45° field of view
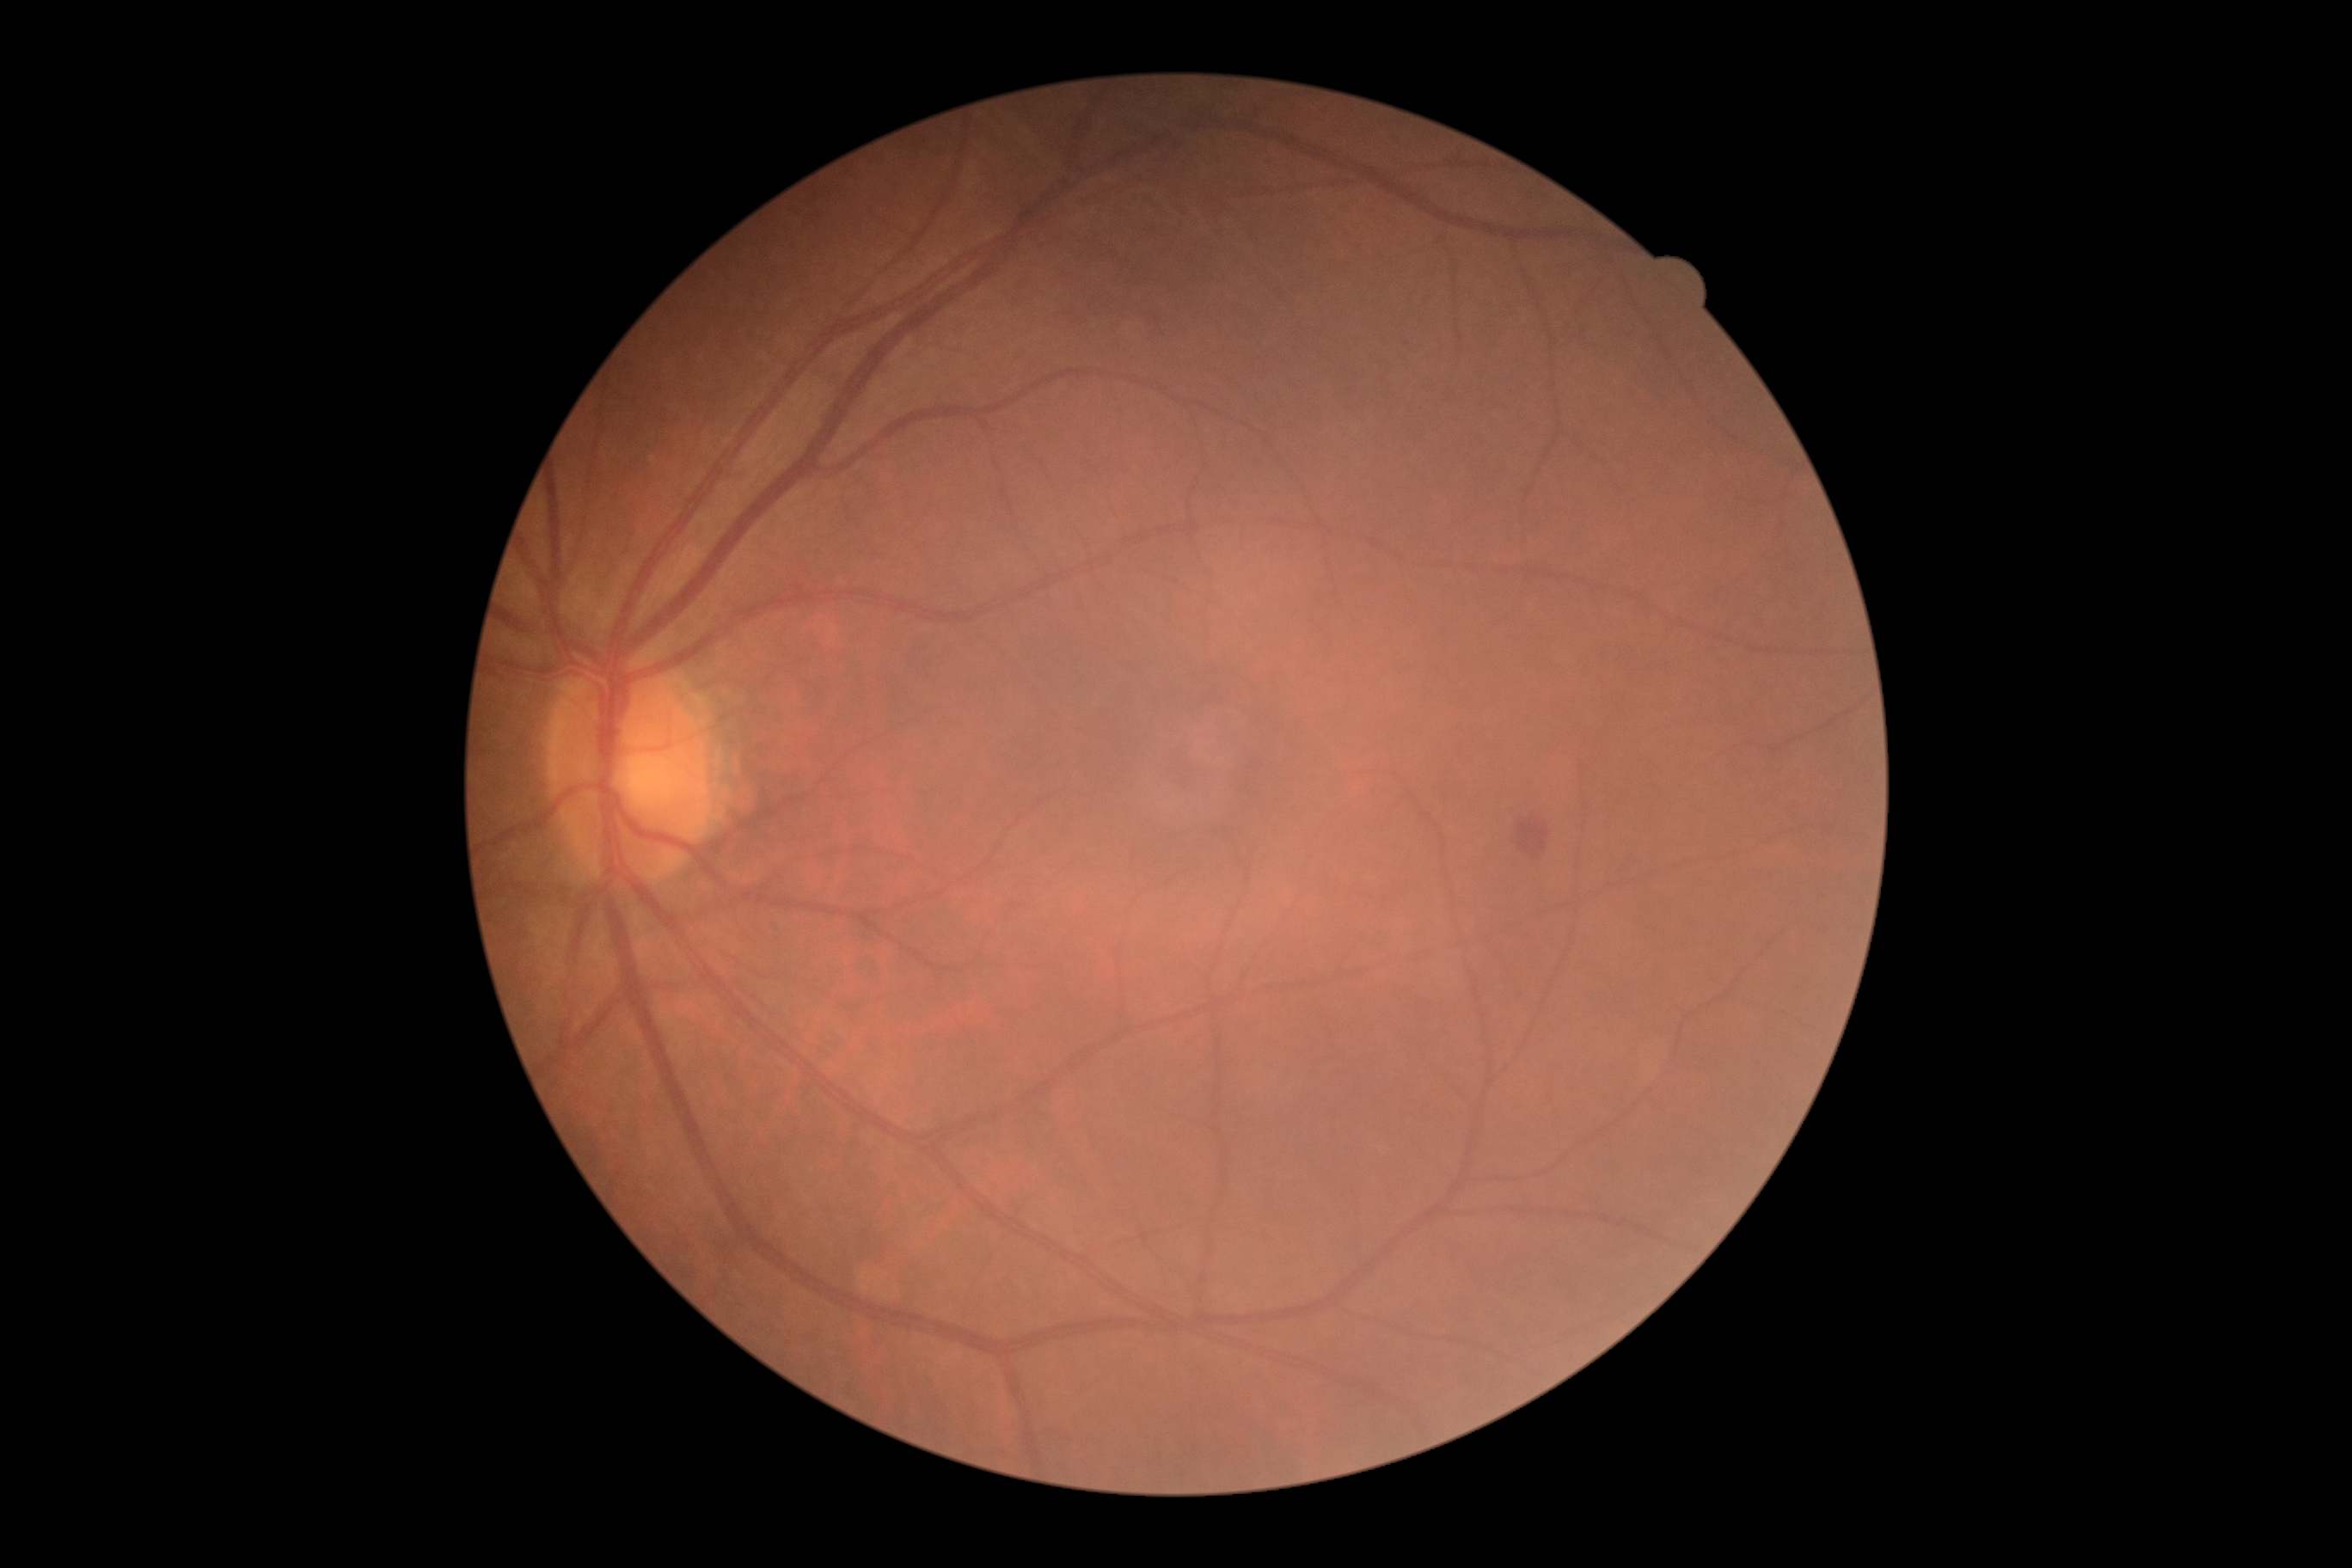 Diabetic retinopathy grade: 2
microaneurysms = none
hard exudates = none
soft exudates = none
hemorrhages = <region>1155, 314, 1160, 322</region>; <region>1517, 819, 1550, 859</region>